Image size 1240x1240. Phoenix ICON wide-field infant fundus image:
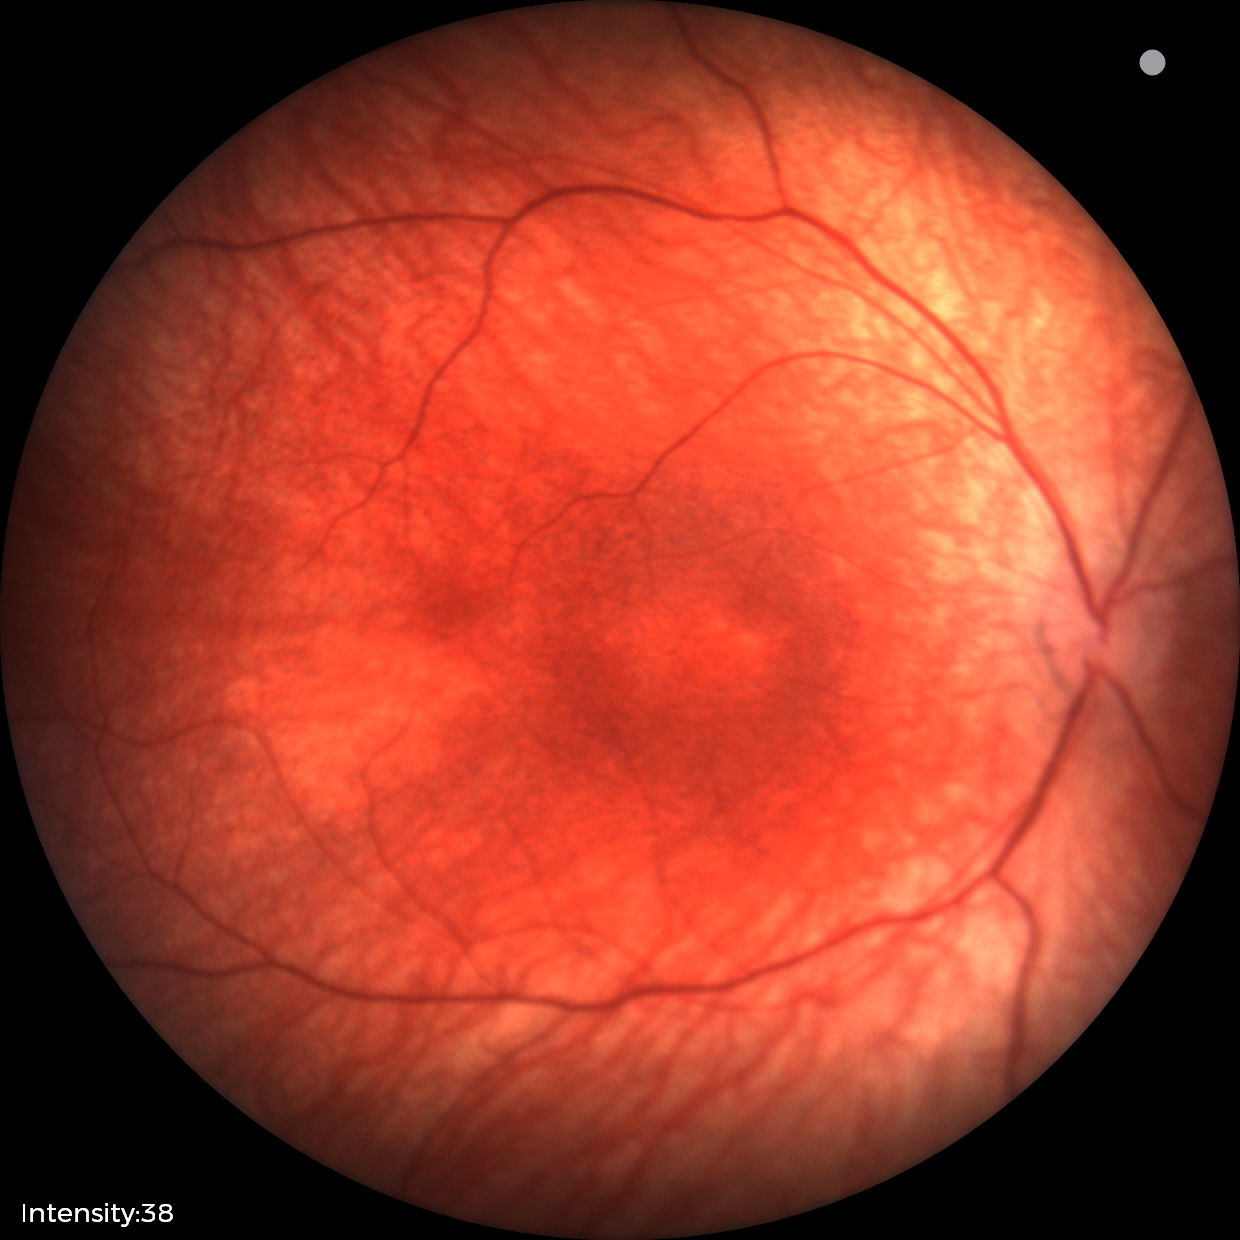
Finding = no abnormalities.